45° FOV · NIDEK AFC-230 · nonmydriatic fundus photograph · color fundus image · 848x848px.
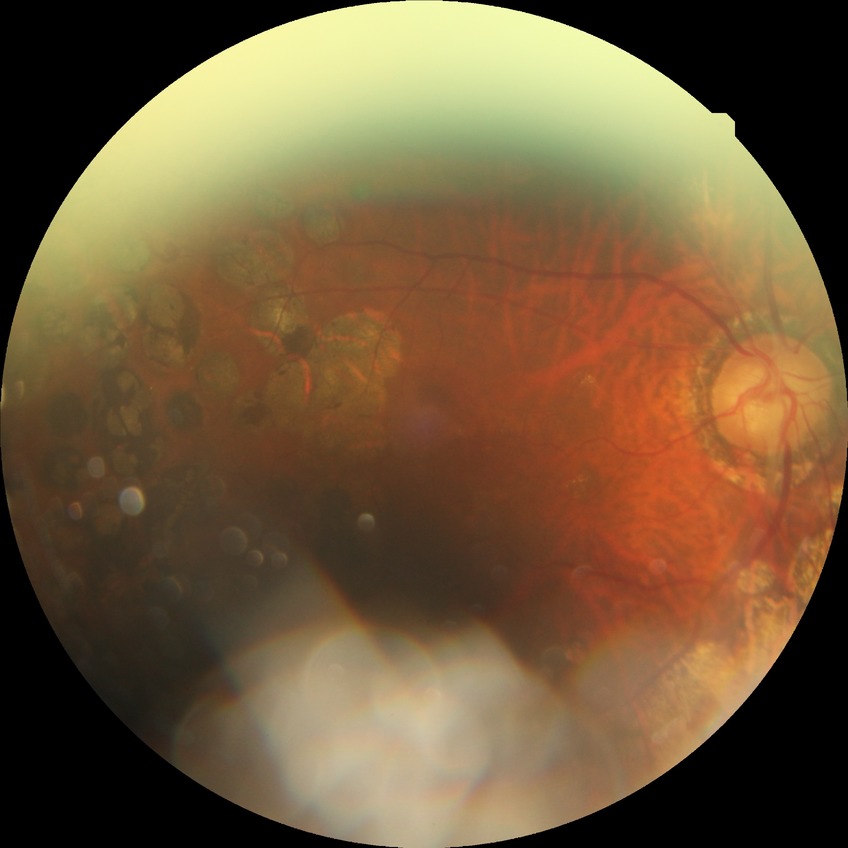
Diabetic retinopathy severity is proliferative diabetic retinopathy.